Nonmydriatic fundus photograph. 45-degree field of view. 848x848px. Posterior pole photograph. Camera: NIDEK AFC-230: 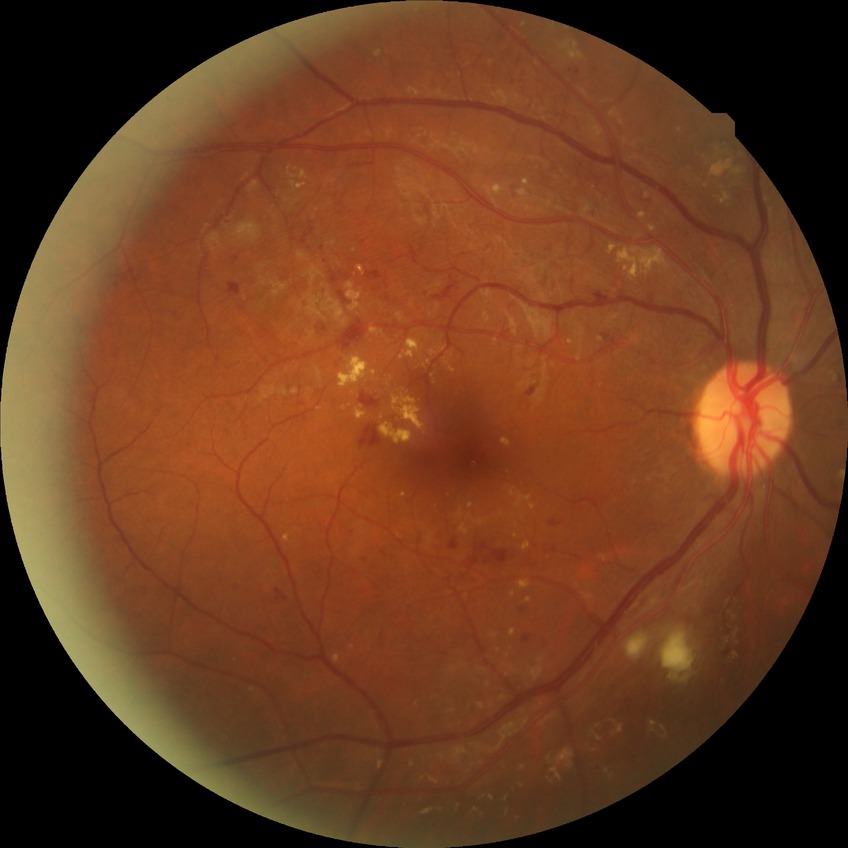
retinopathy grade = pre-proliferative diabetic retinopathy | DR class = non-proliferative diabetic retinopathy.